RetCam wide-field infant fundus image. Image size 640x480 — 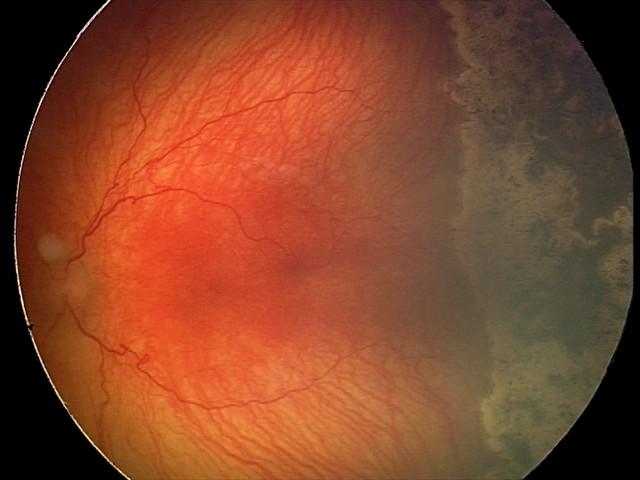 Plus disease present.
Screening examination consistent with aggressive retinopathy of prematurity (A-ROP).